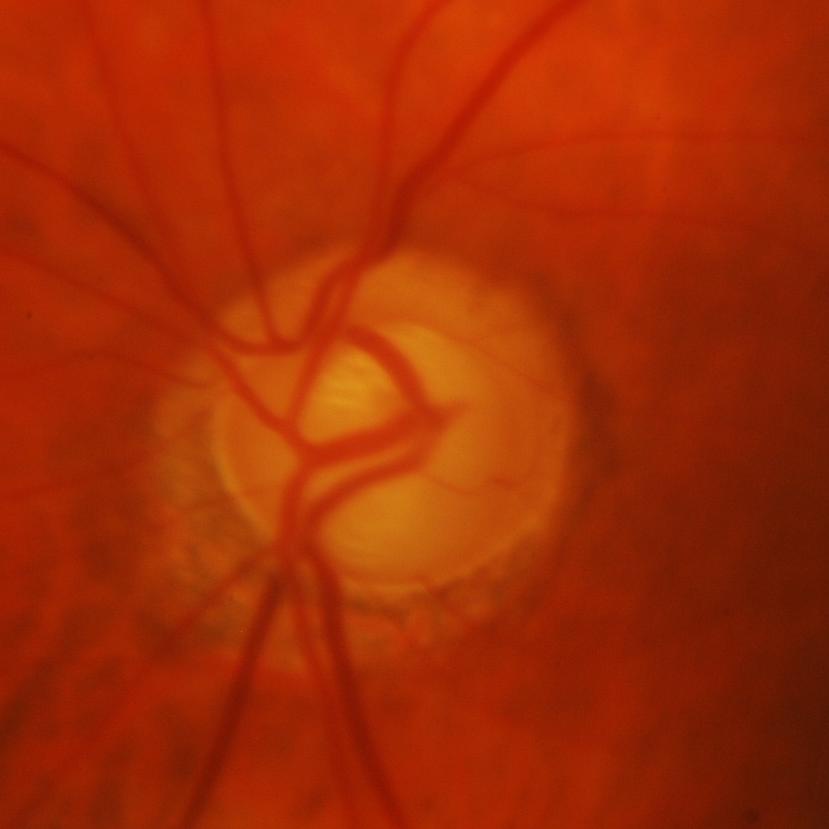 Demonstrates glaucoma.